45° field of view; 848 x 848 pixels; nonmydriatic fundus photograph.
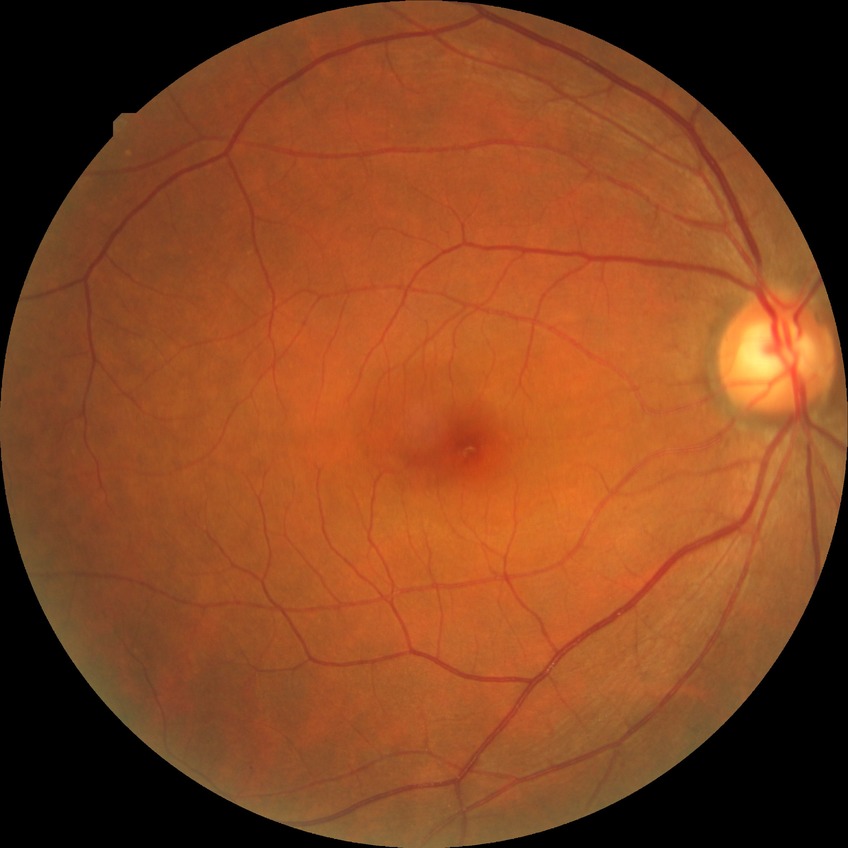
diabetic retinopathy (DR) = NDR (no diabetic retinopathy).